Posterior pole color fundus photograph, NIDEK AFC-230 fundus camera, image size 848x848
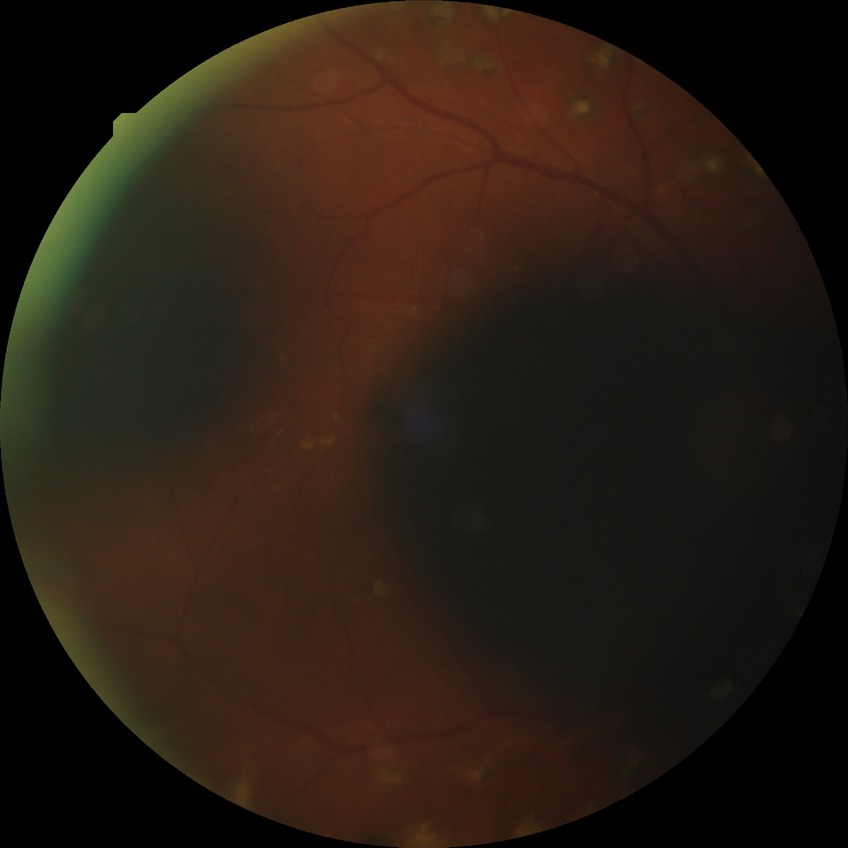 Diabetic retinopathy (DR): PDR (proliferative diabetic retinopathy).